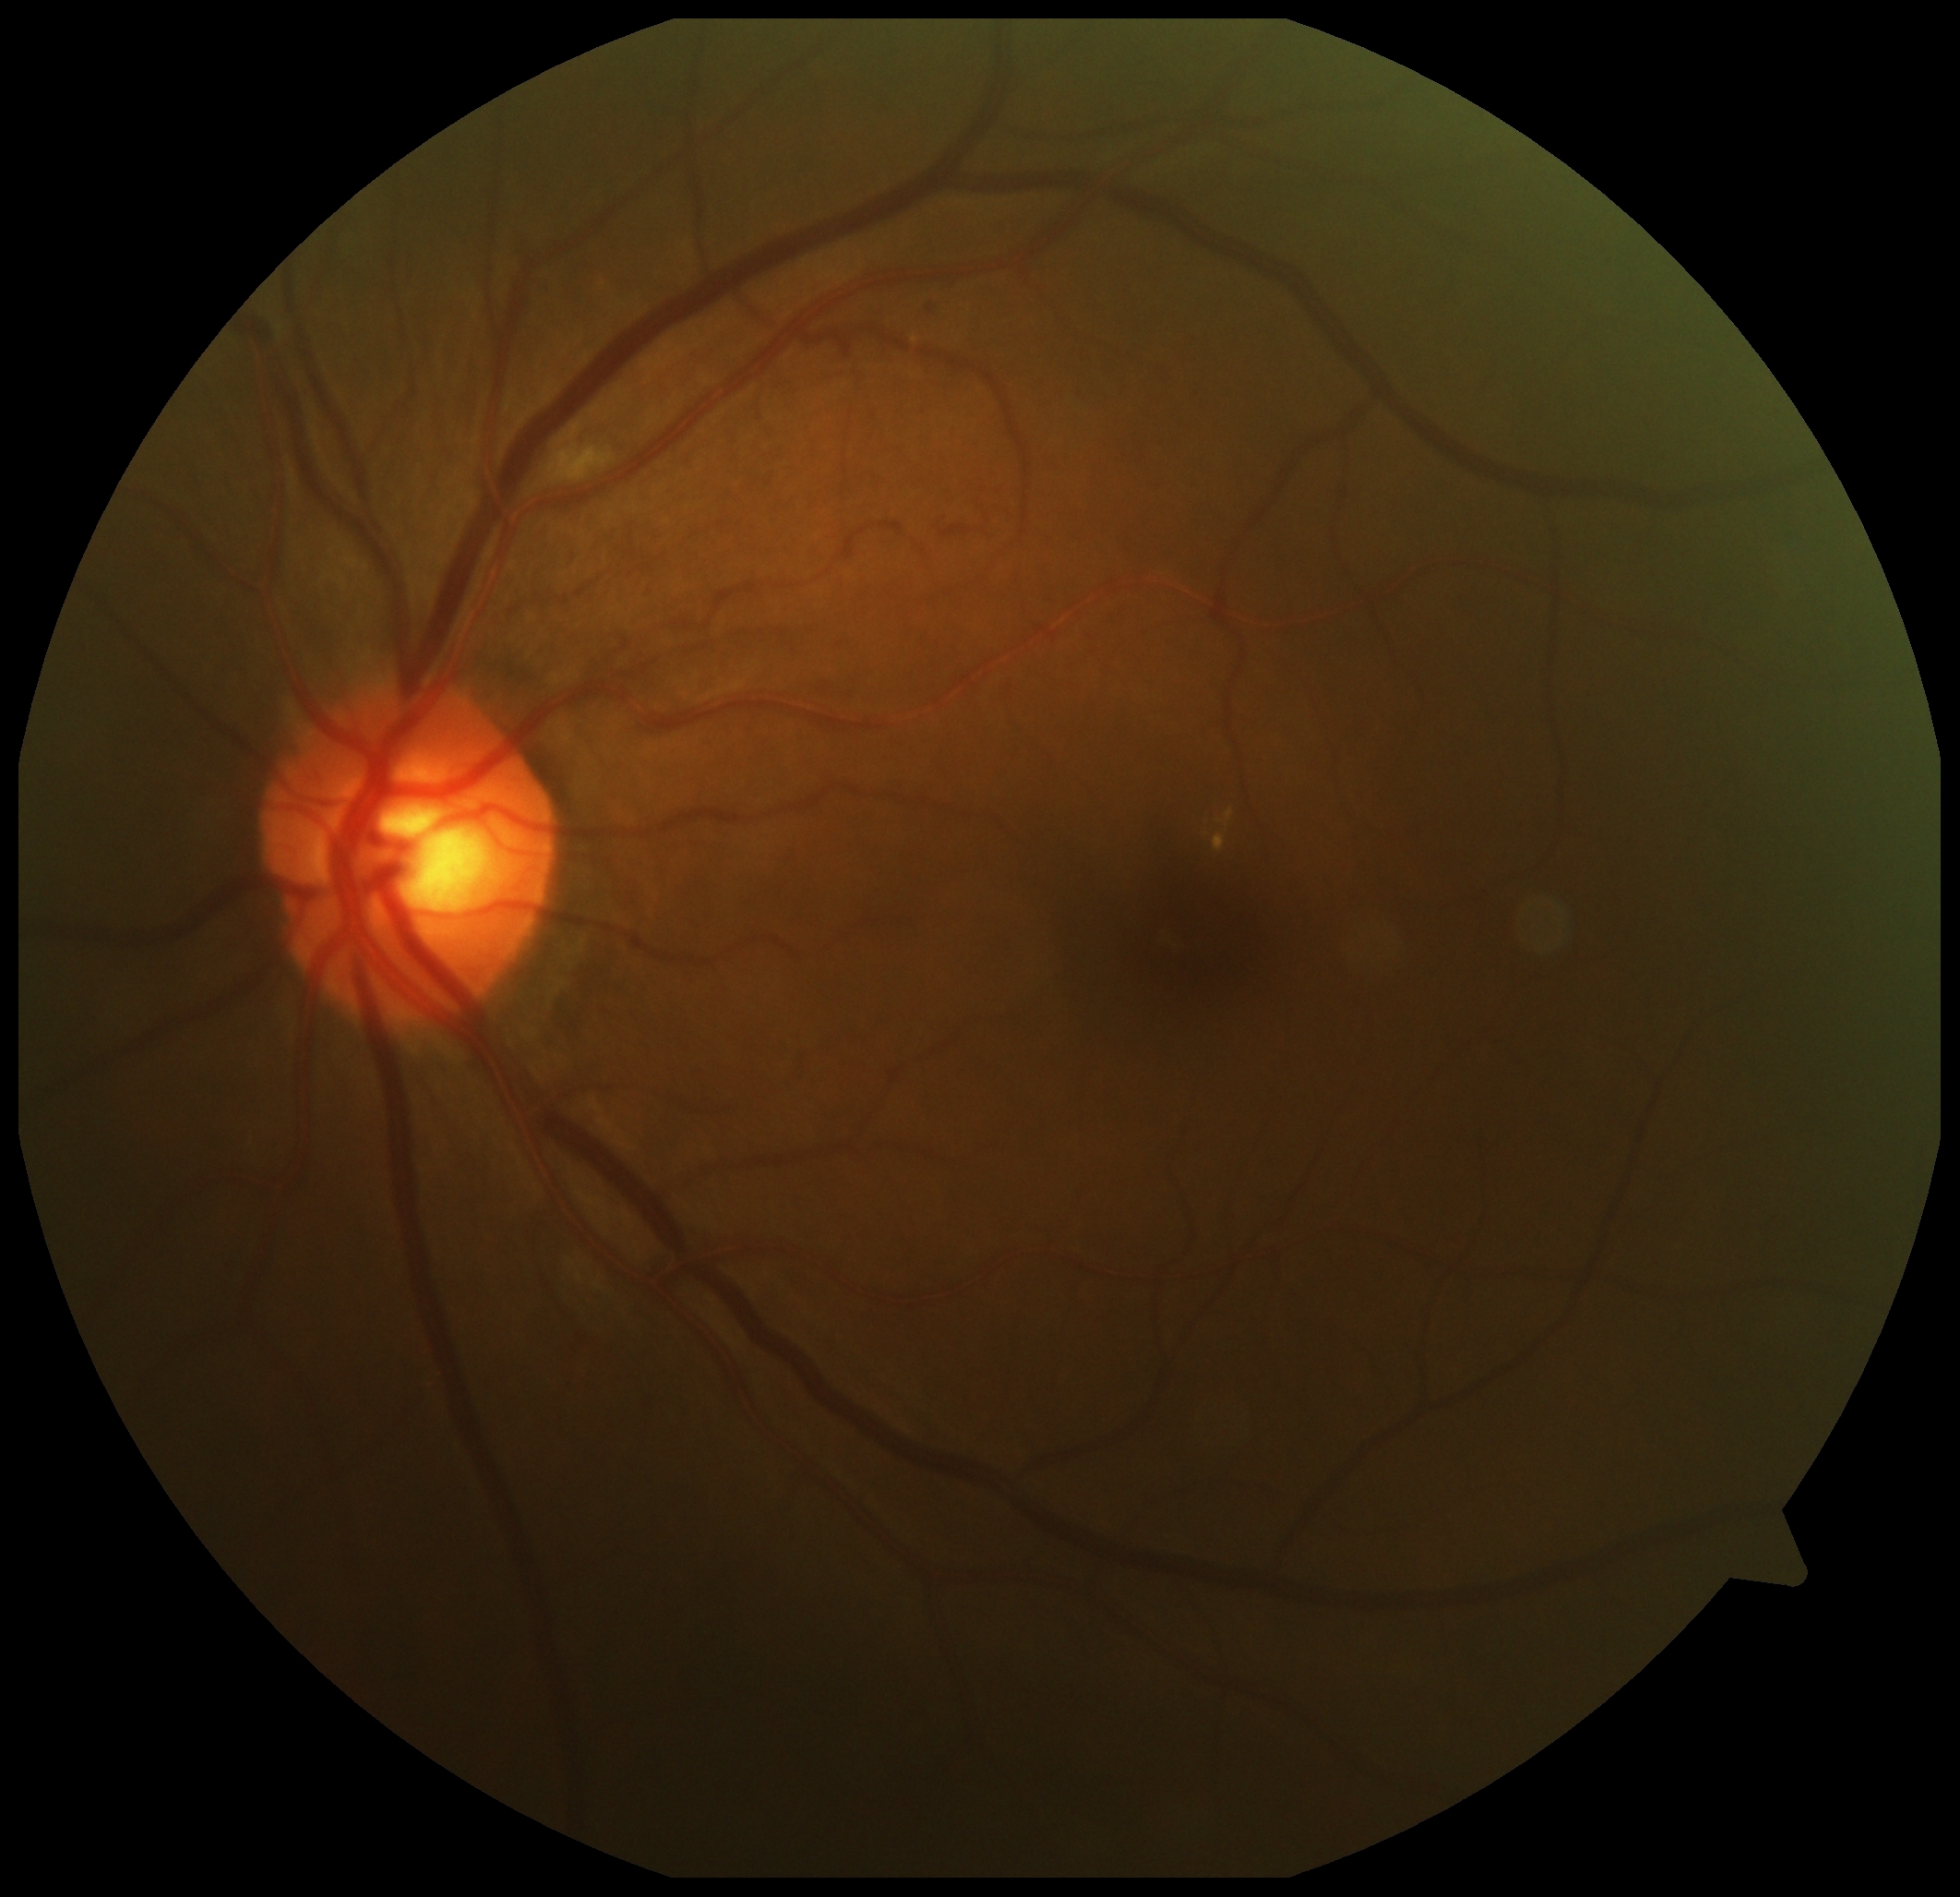   dr_grade: grade 2 (moderate NPDR)